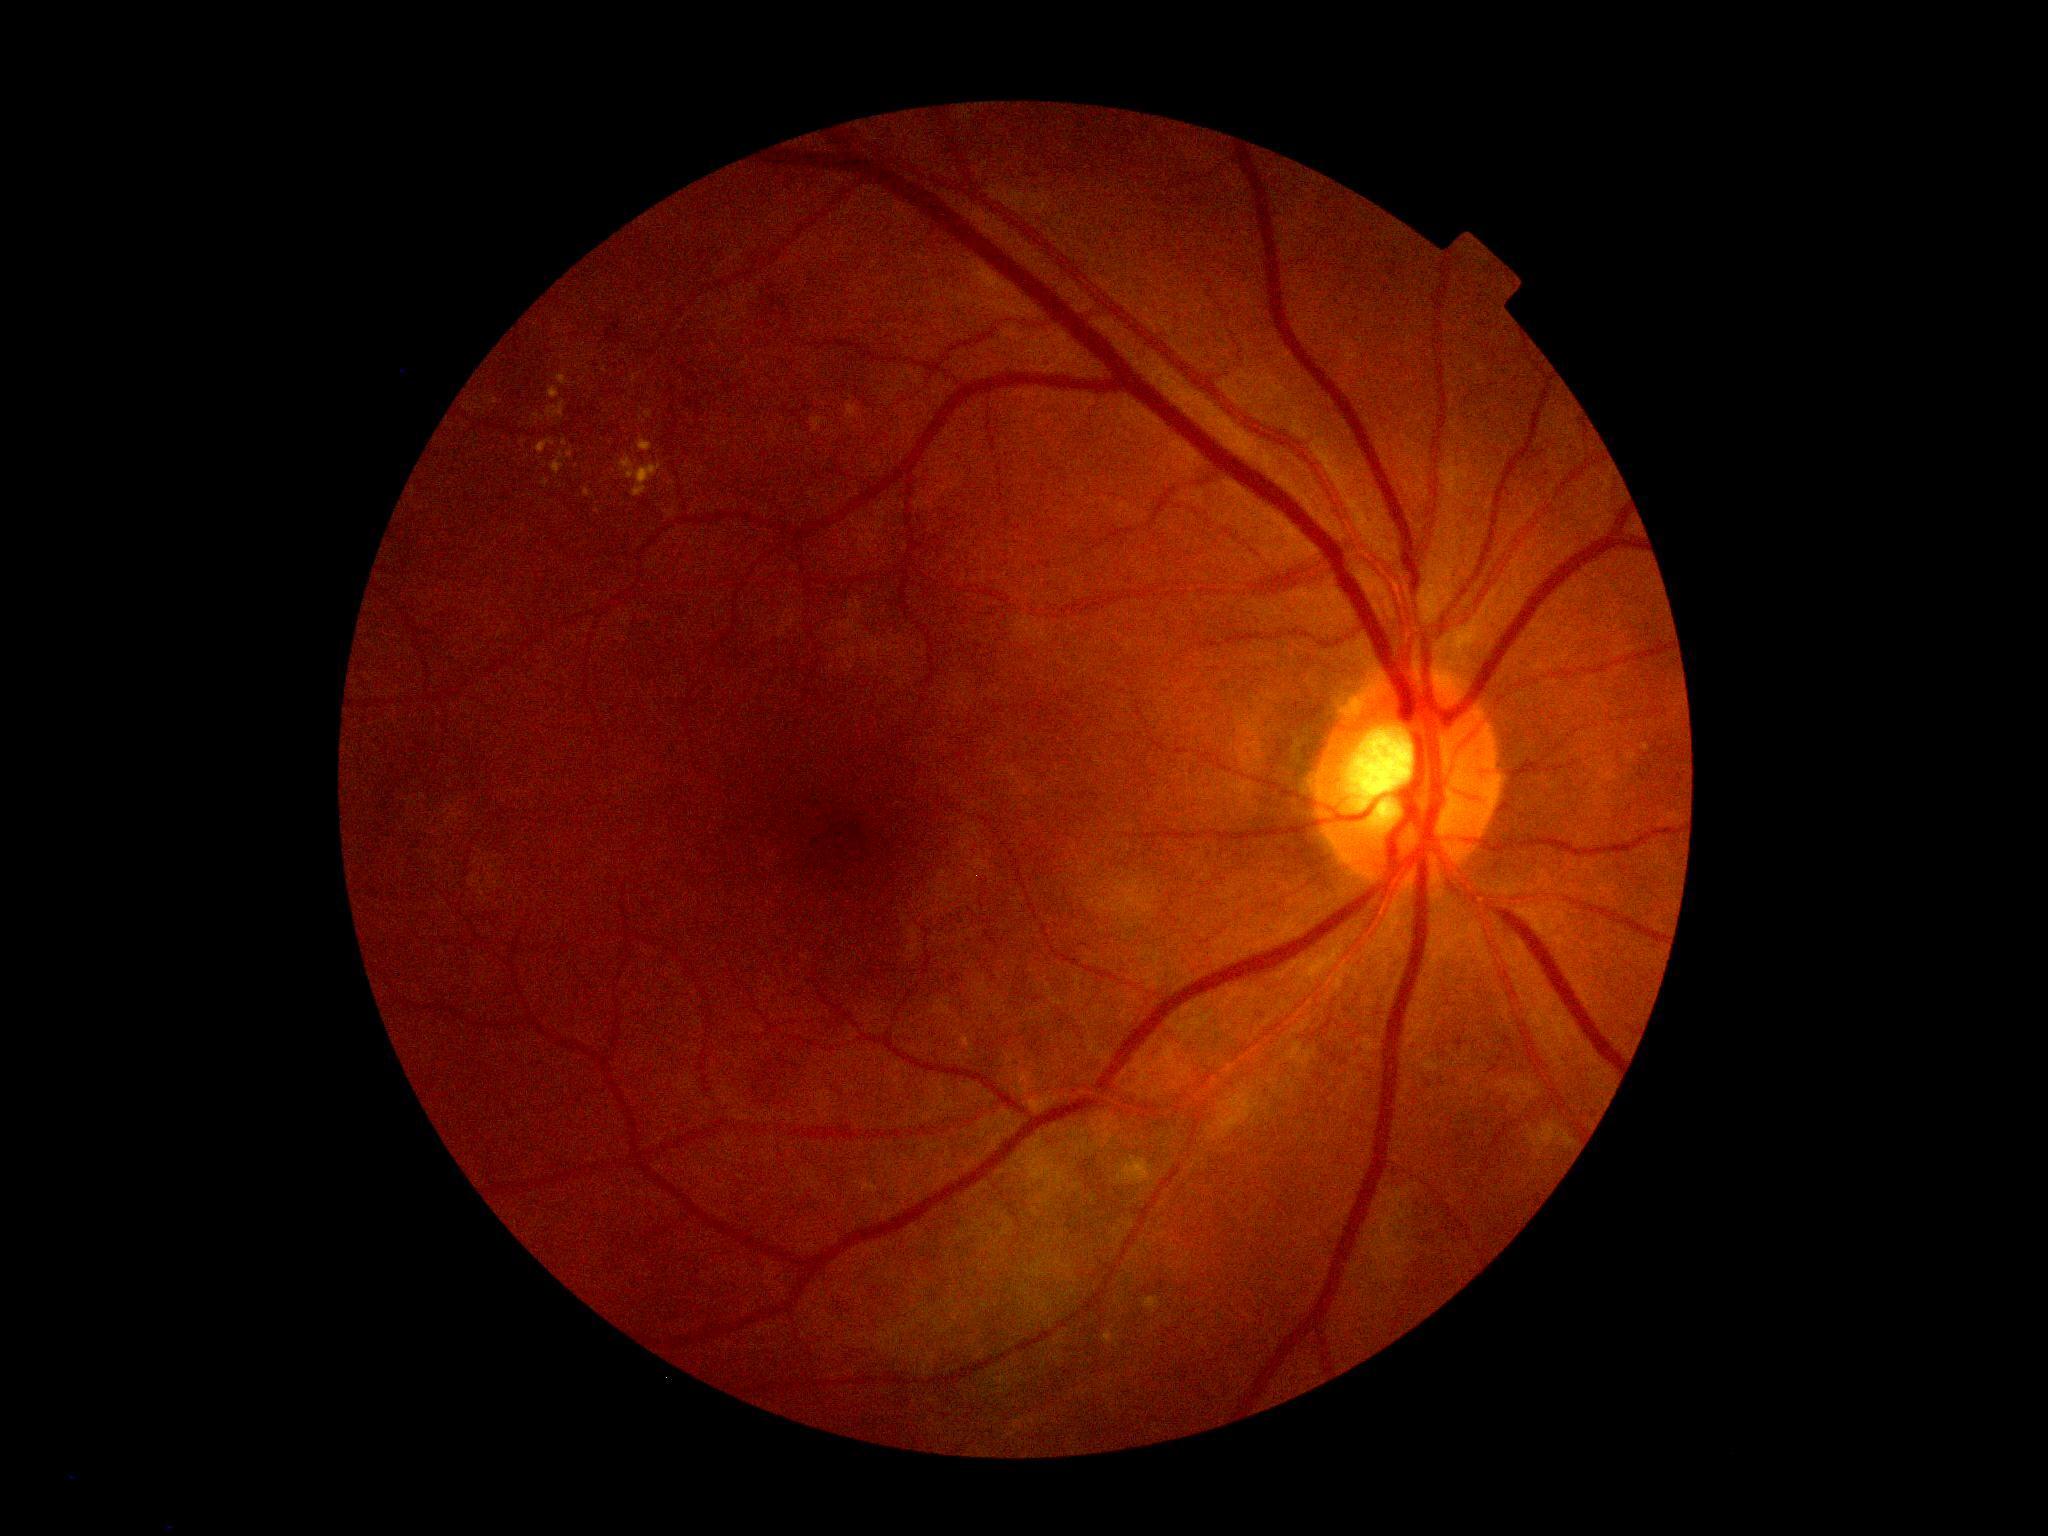
{"dr_grade": "grade 2"}